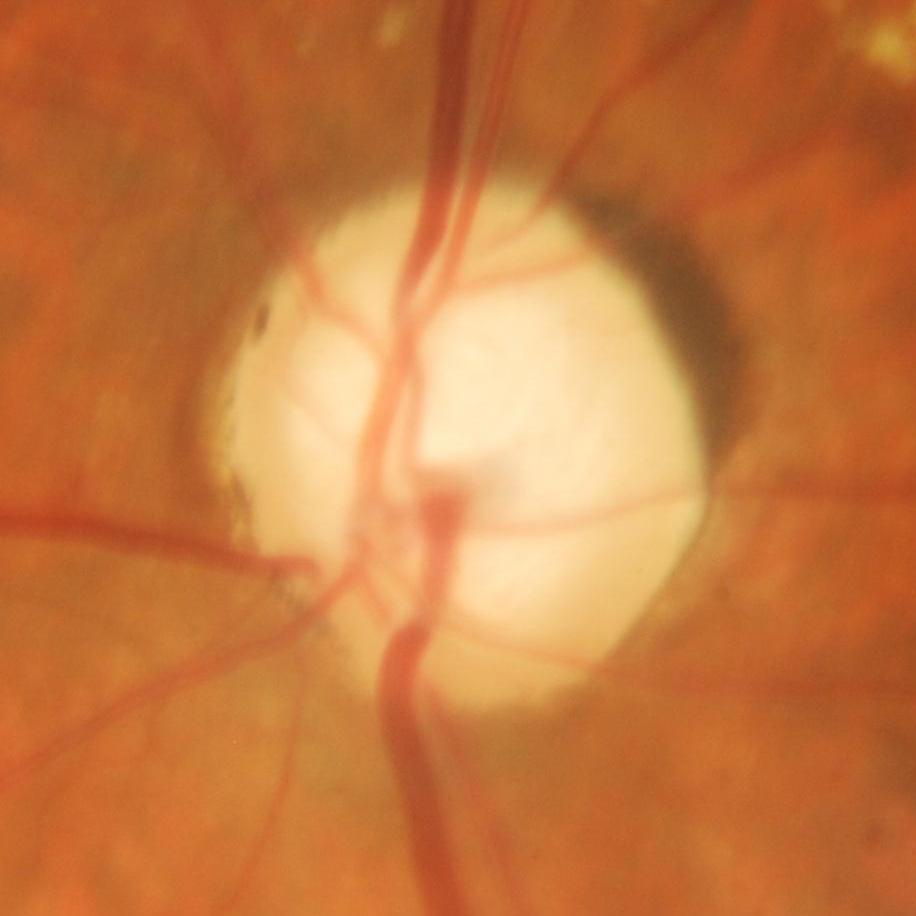
Q: Glaucoma assessment?
A: Evidence of glaucoma.